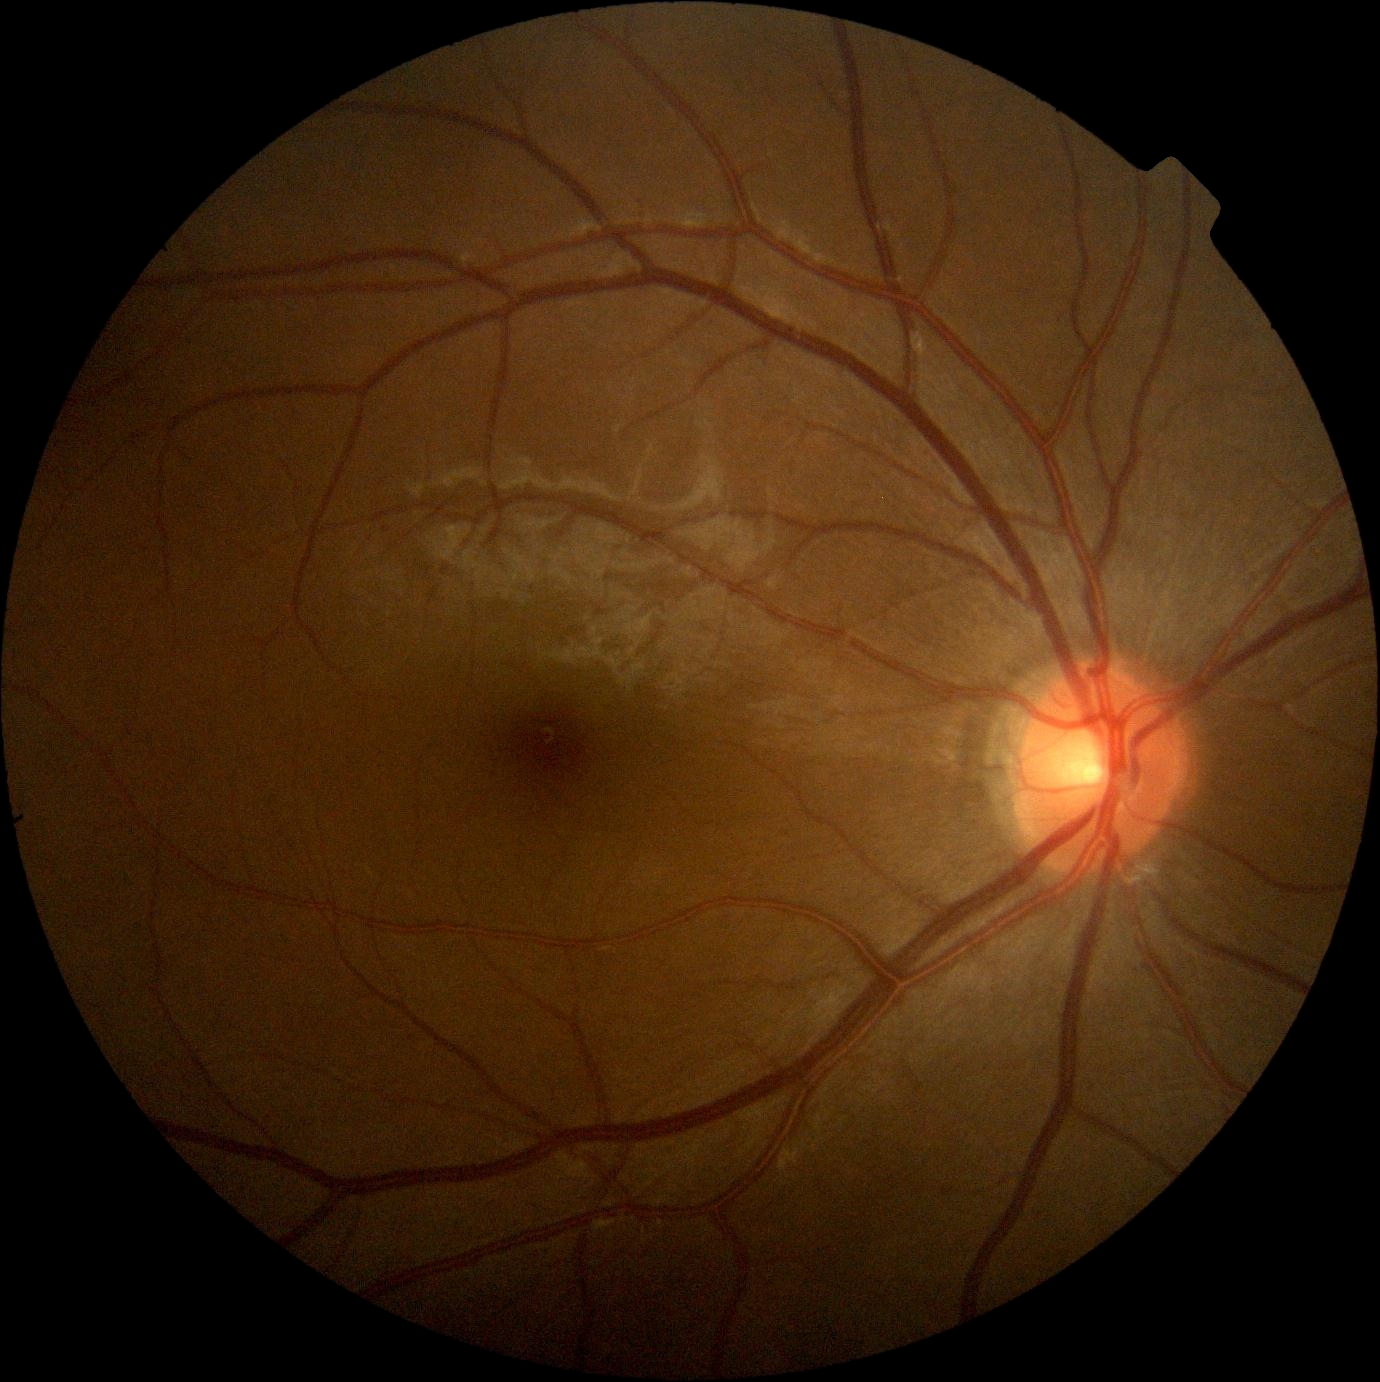
DR grade@0 — no visible signs of diabetic retinopathy, DR impression@no DR findings.